45° FOV, nonmydriatic fundus photograph, 848x848px:
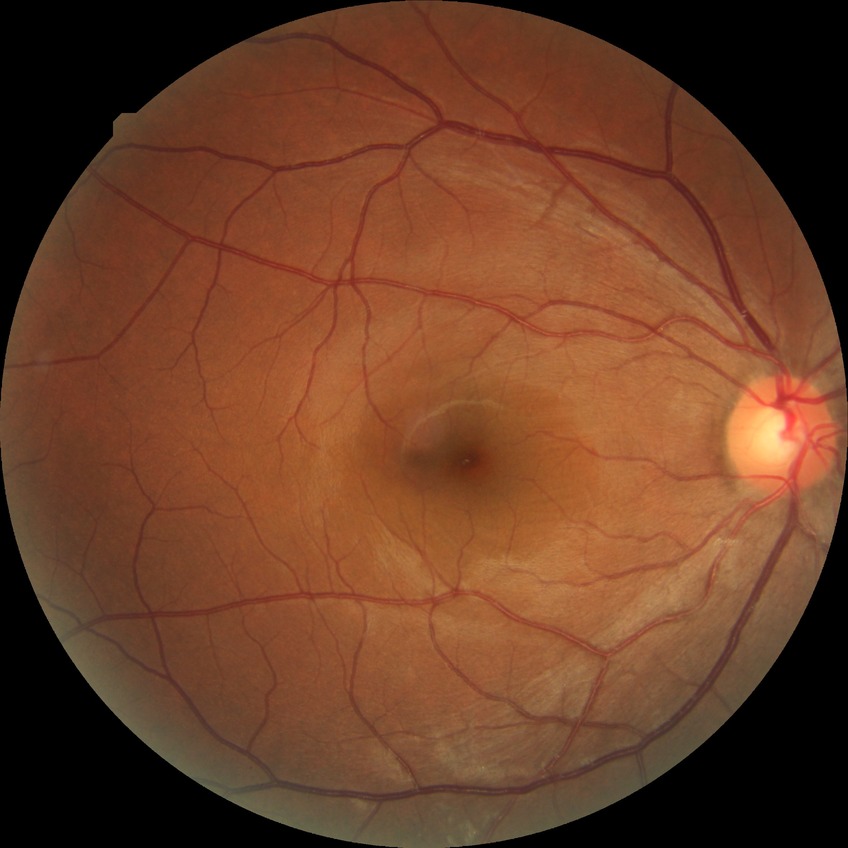

modified Davis grading@no diabetic retinopathy.